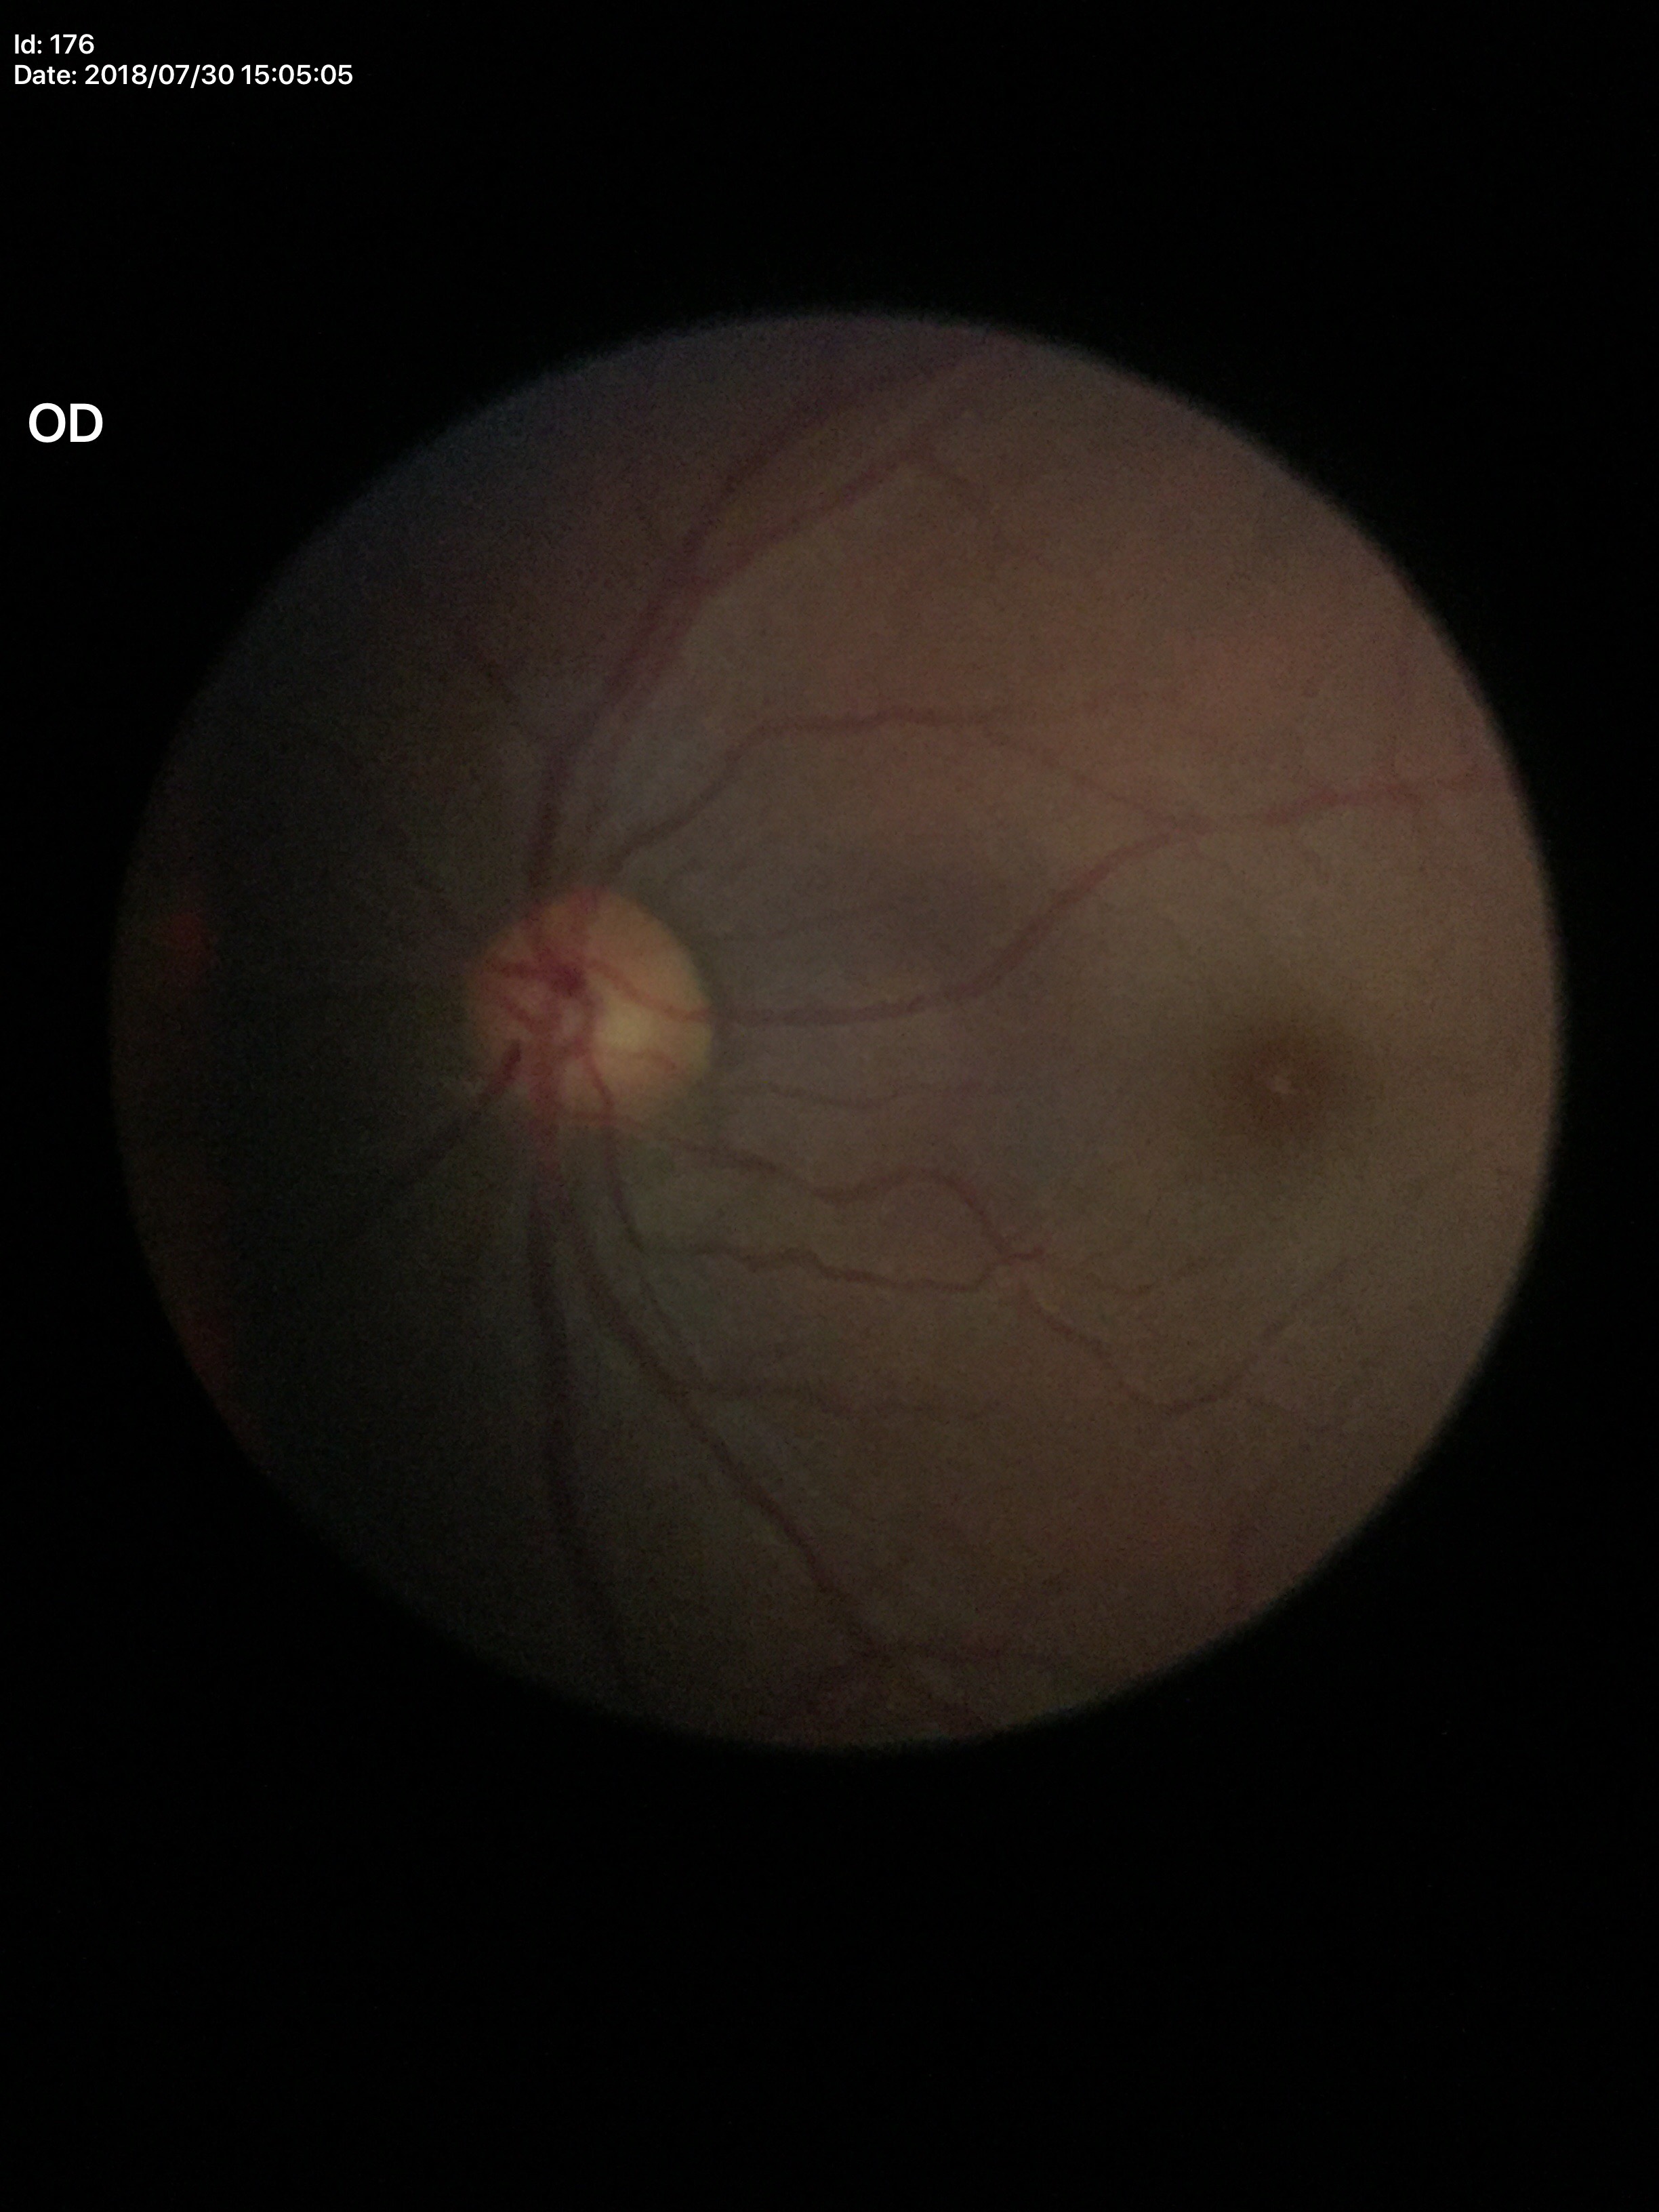
Glaucoma decision=not suspect | area cup-disc ratio=0.26 | vertical cup-disc ratio=0.52